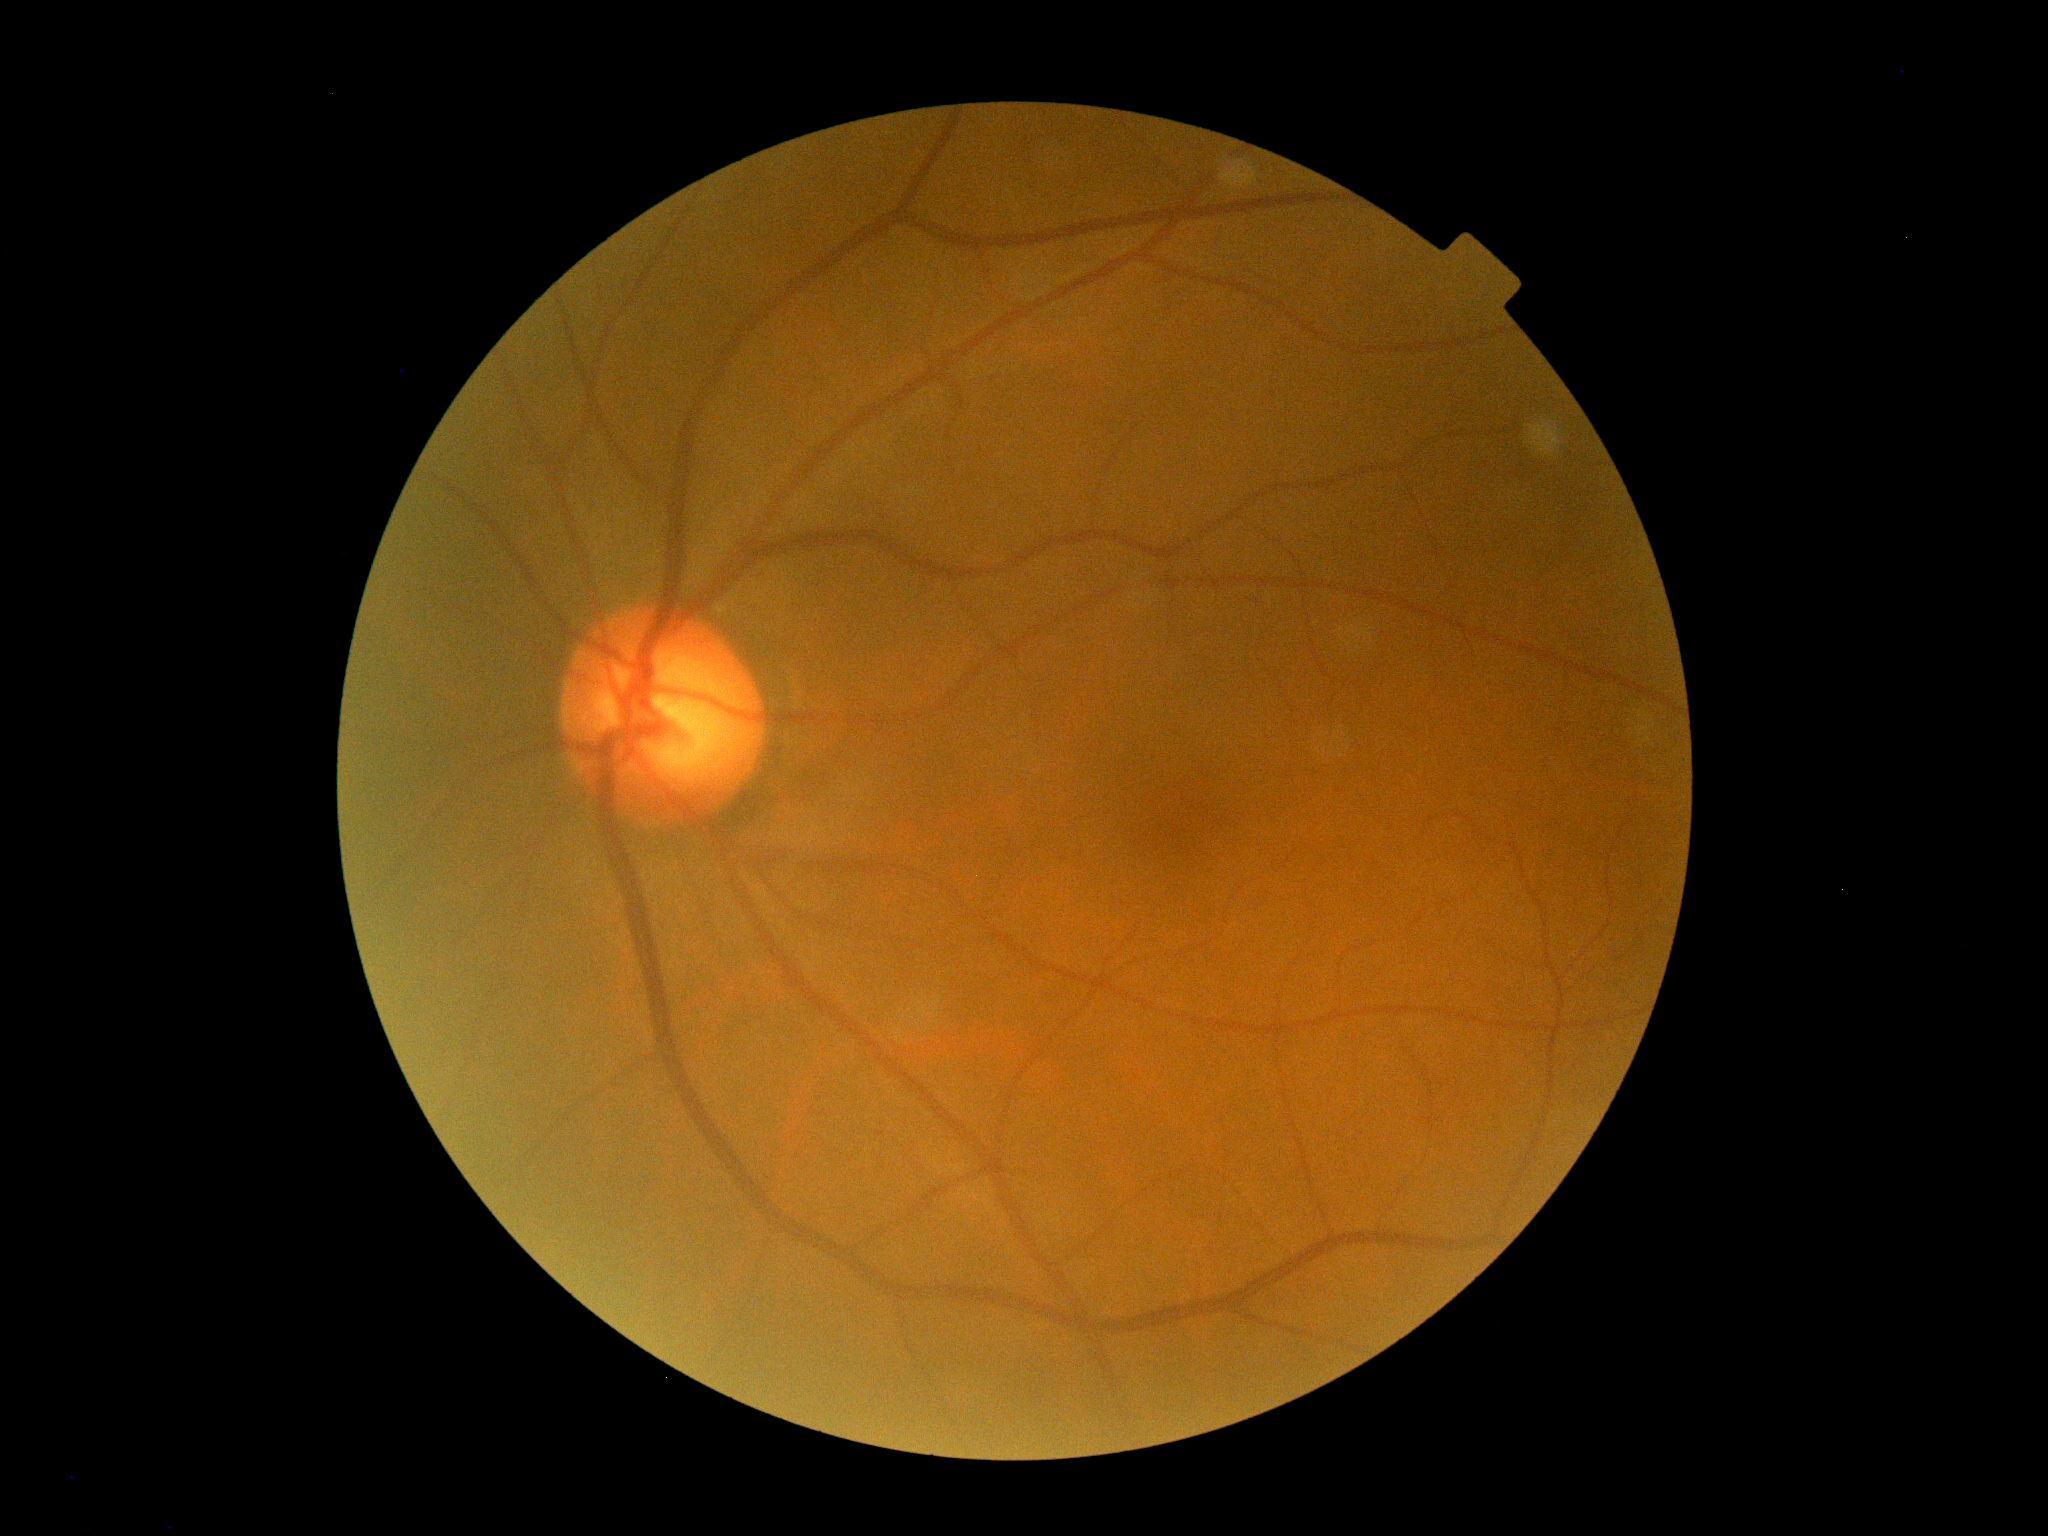

No apparent diabetic retinopathy.
DR grade is no apparent retinopathy (0).